Color fundus image
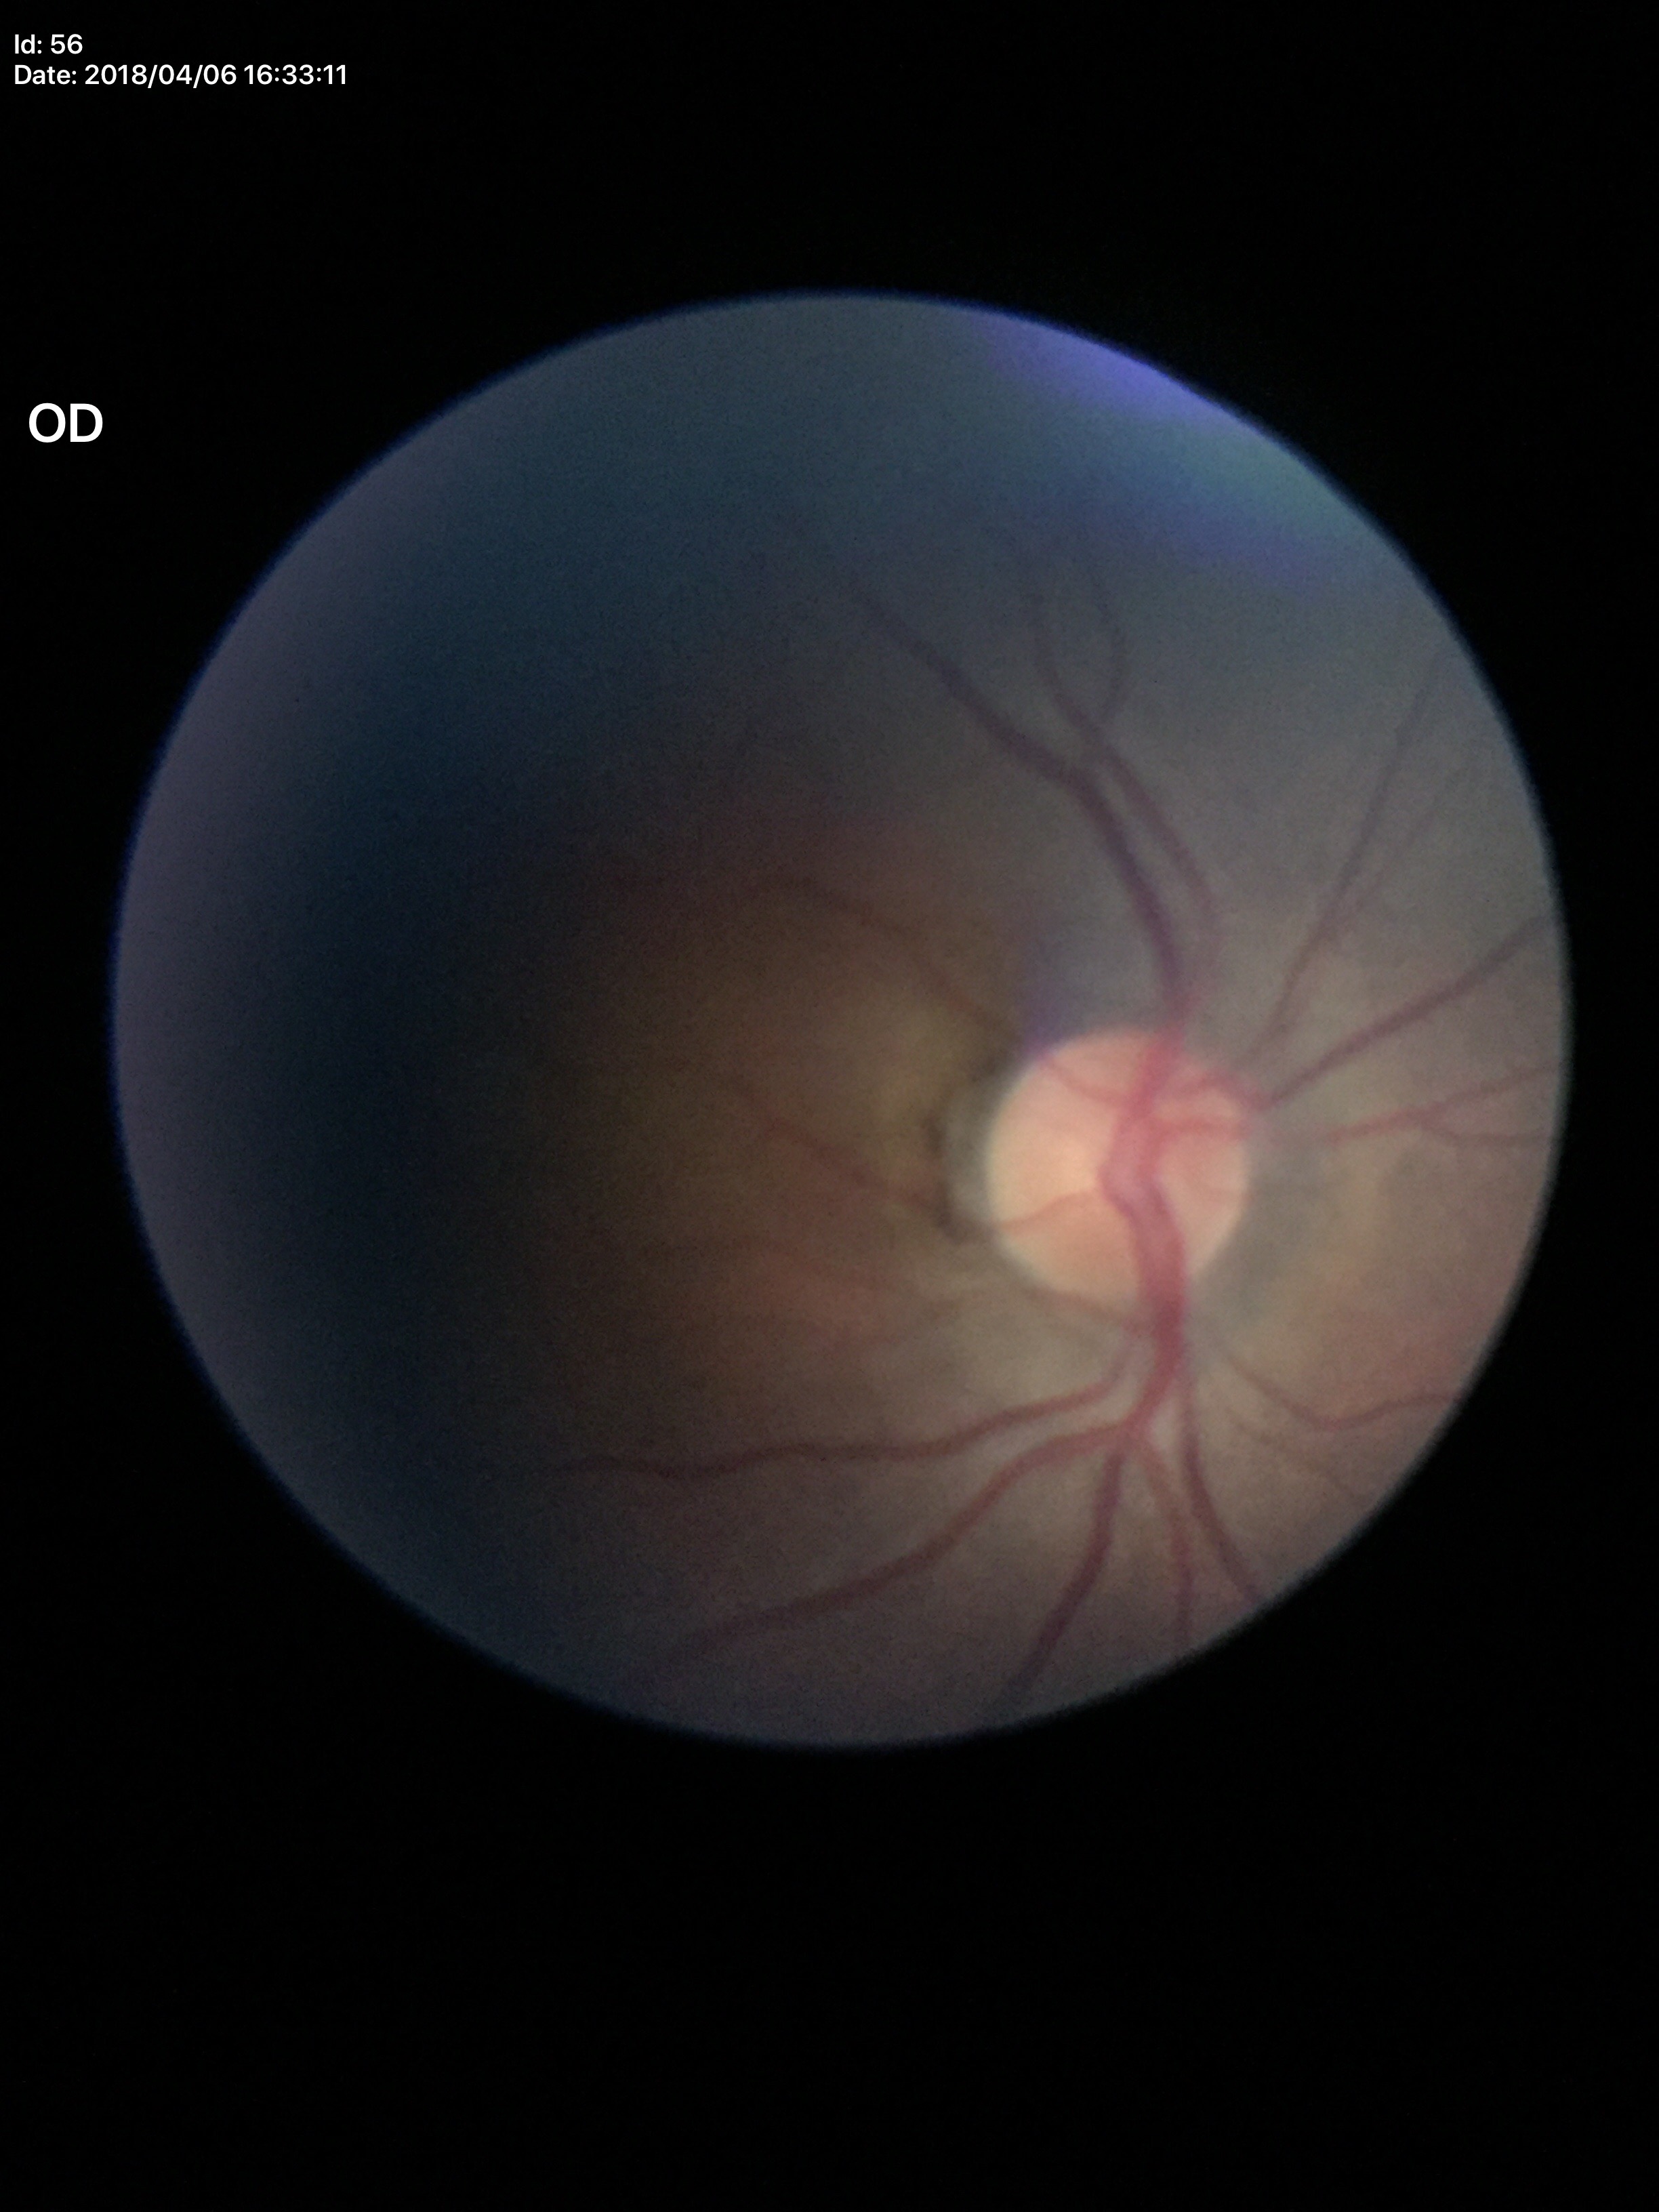 No glaucomatous findings. Horizontal cup-to-disc ratio (HCDR): 0.44. Vertical C/D ratio (VCDR) is 0.49.